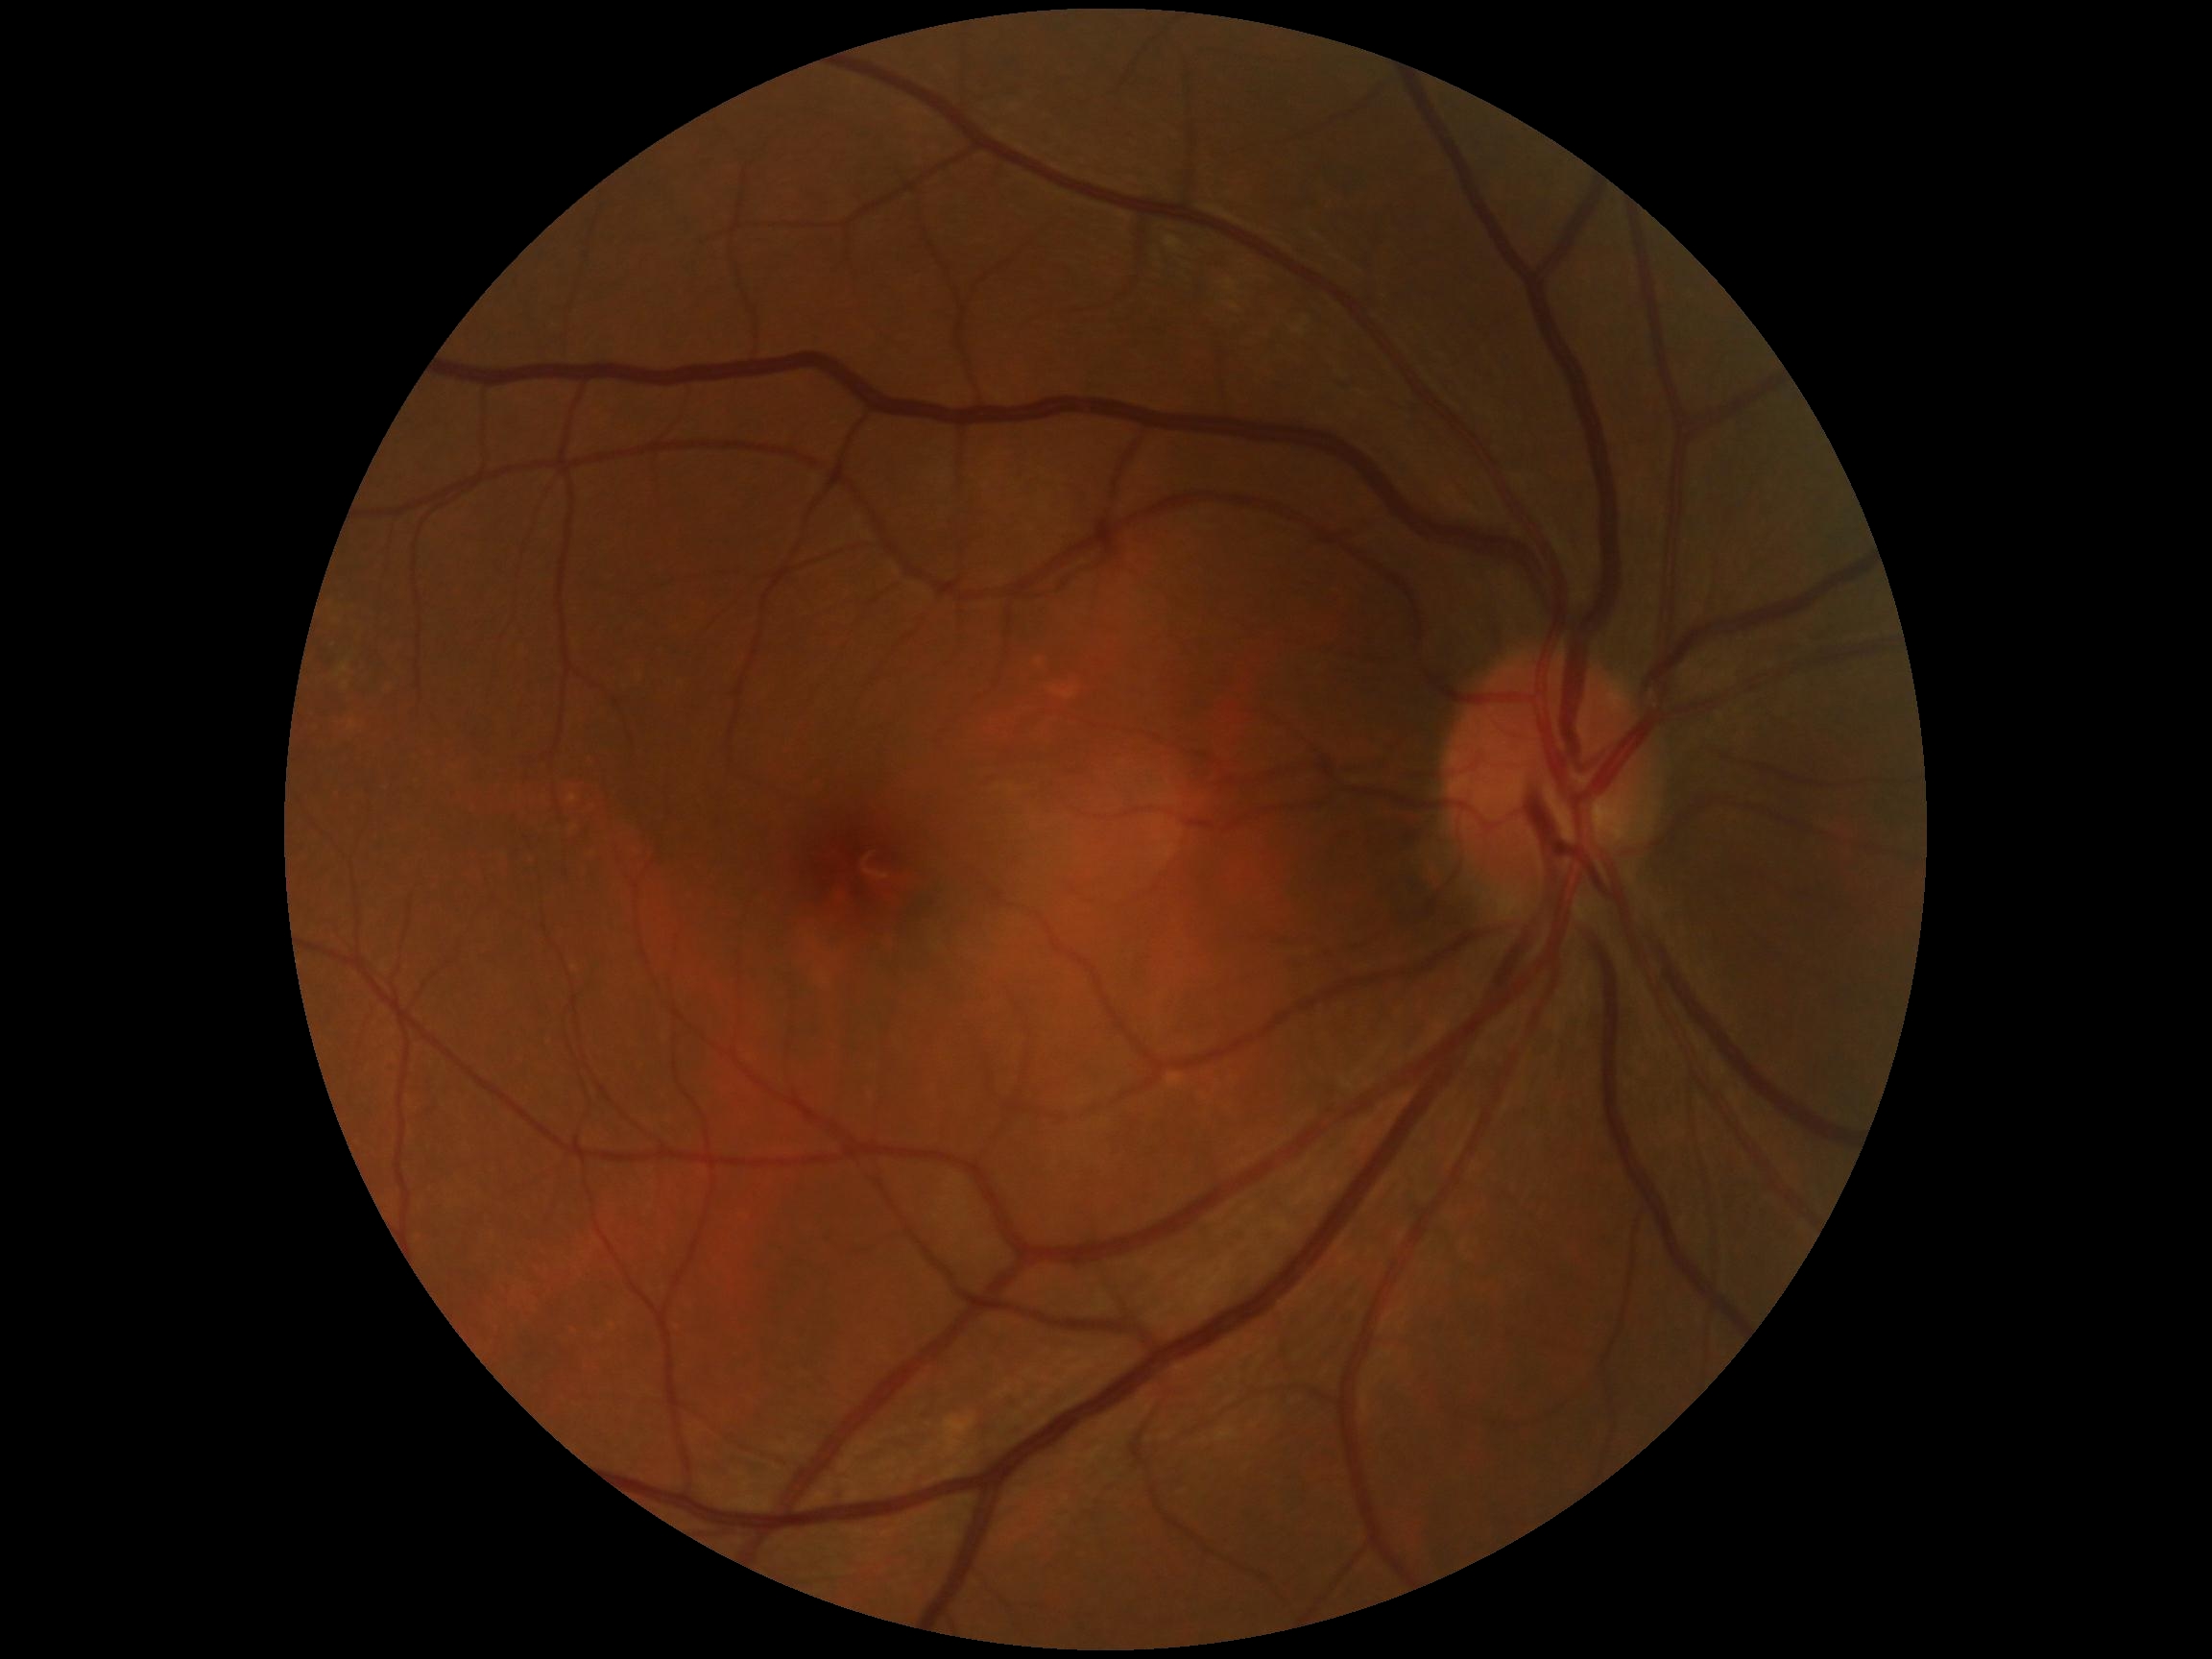

No DR findings. Diabetic retinopathy (DR): 0 — no visible signs of diabetic retinopathy.